Acquired on the Clarity RetCam 3; pediatric wide-field fundus photograph:
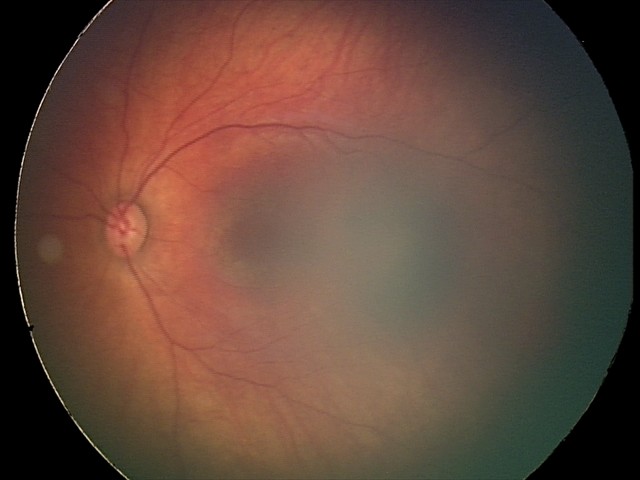 Diagnosis from this screening exam: retinal hemorrhages.